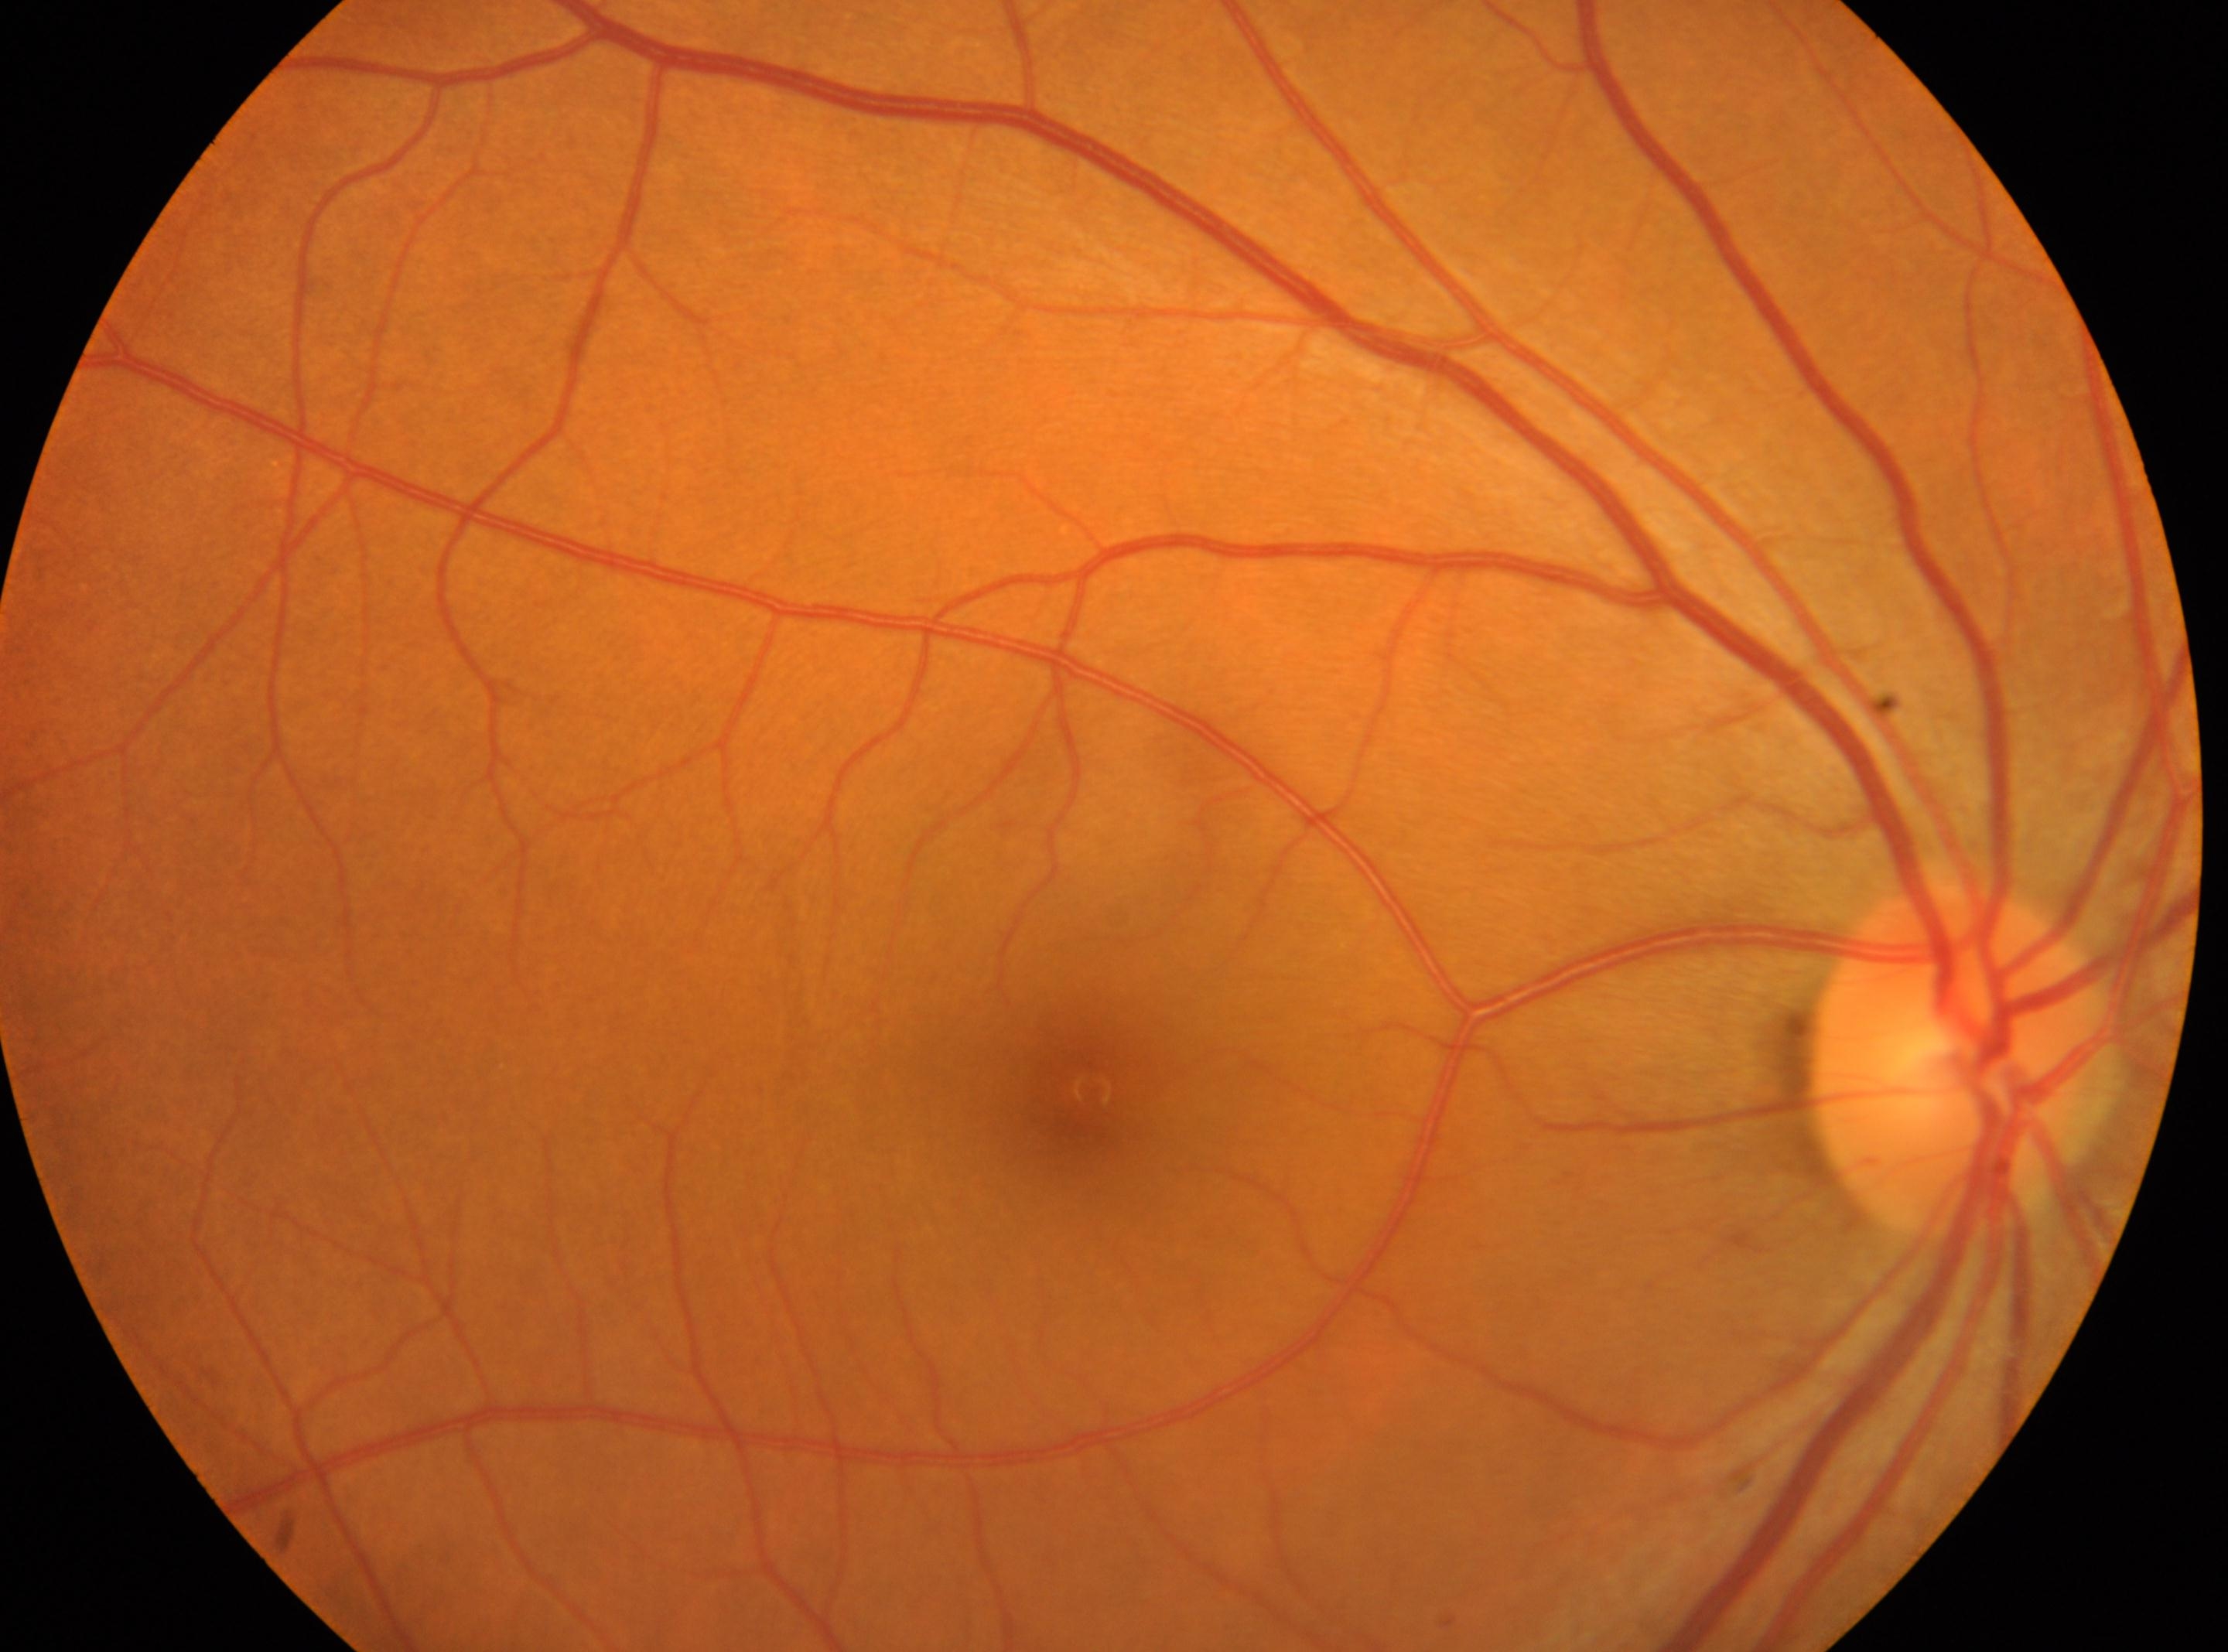
Macula center: (x=1080, y=1089).
Imaged eye: oculus dexter.
Diabetic retinopathy (DR): no apparent retinopathy (grade 0).
The disc center is at (x=1953, y=1060).